Dilated-pupil acquisition. Posterior pole field covering the optic disc and macula. FOV: 50 degrees. Captured on a Topcon TRC-50DX fundus camera. Color fundus image.
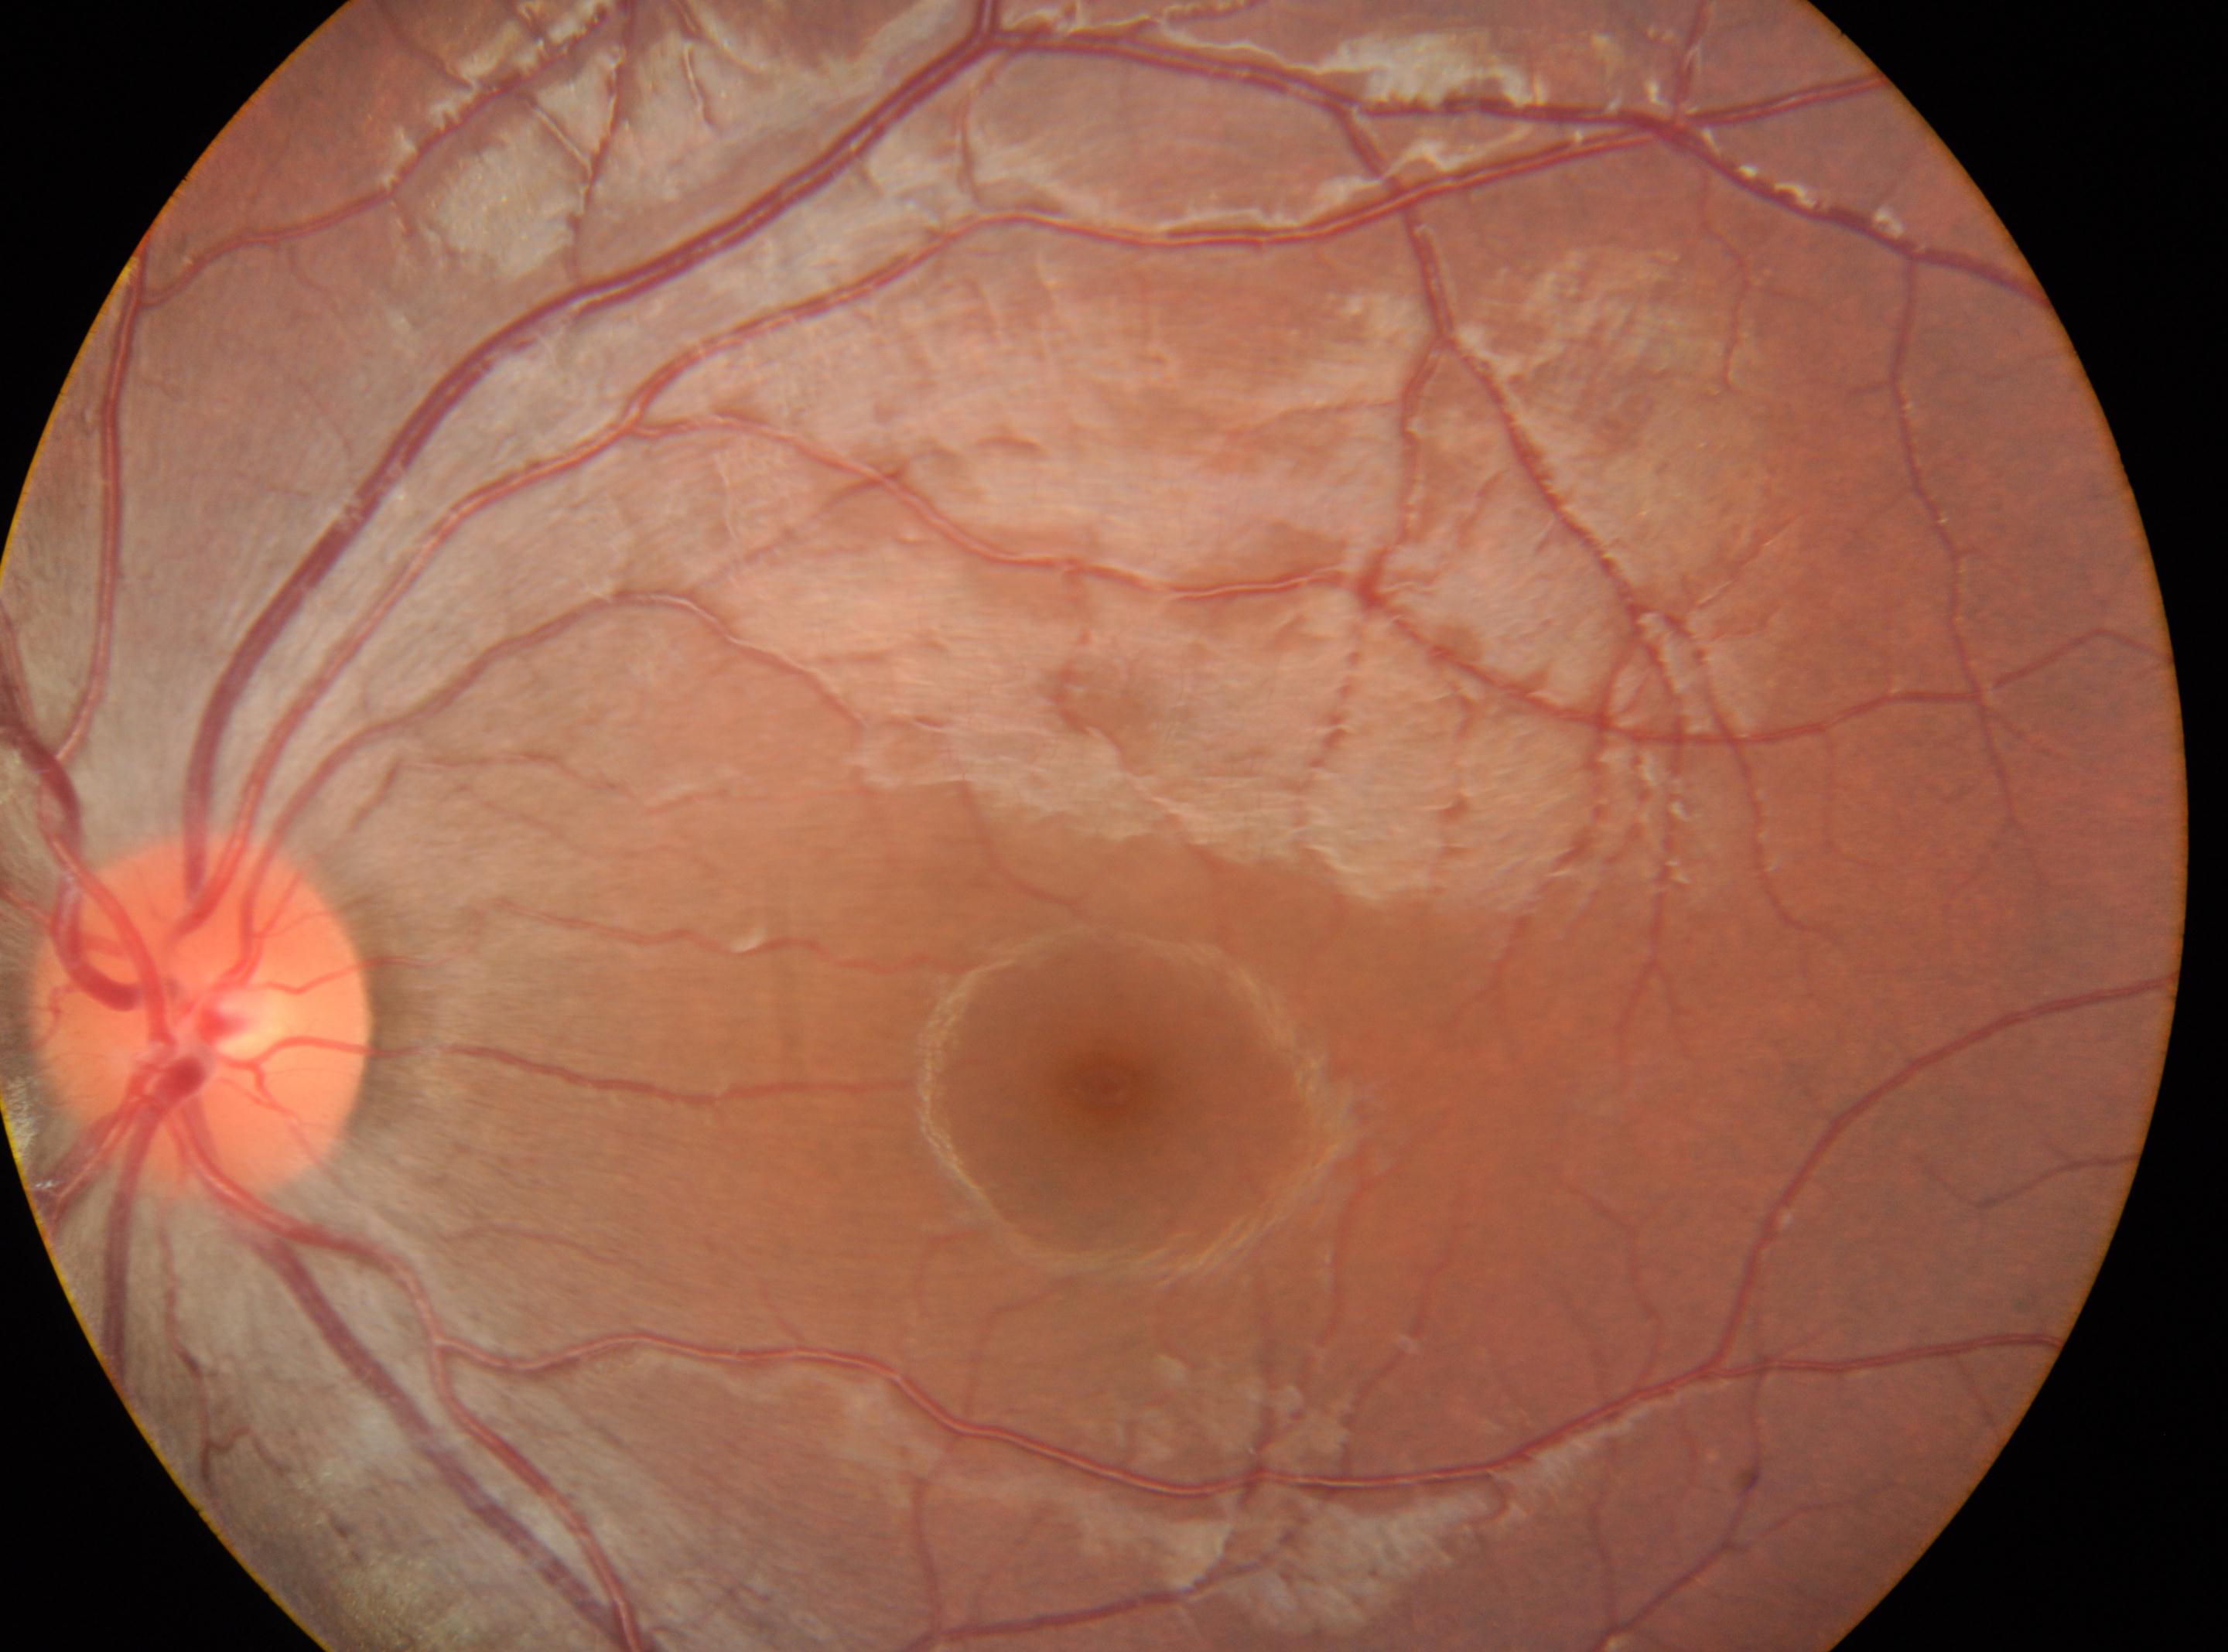 Q: Where is the fovea?
A: 1106px, 1084px
Q: Right or left eye?
A: left
Q: Optic disc center?
A: 201px, 1015px
Q: What is the DR grade?
A: 0 (no apparent retinopathy) — no visible signs of diabetic retinopathy